Modified Davis classification, image size 848x848.
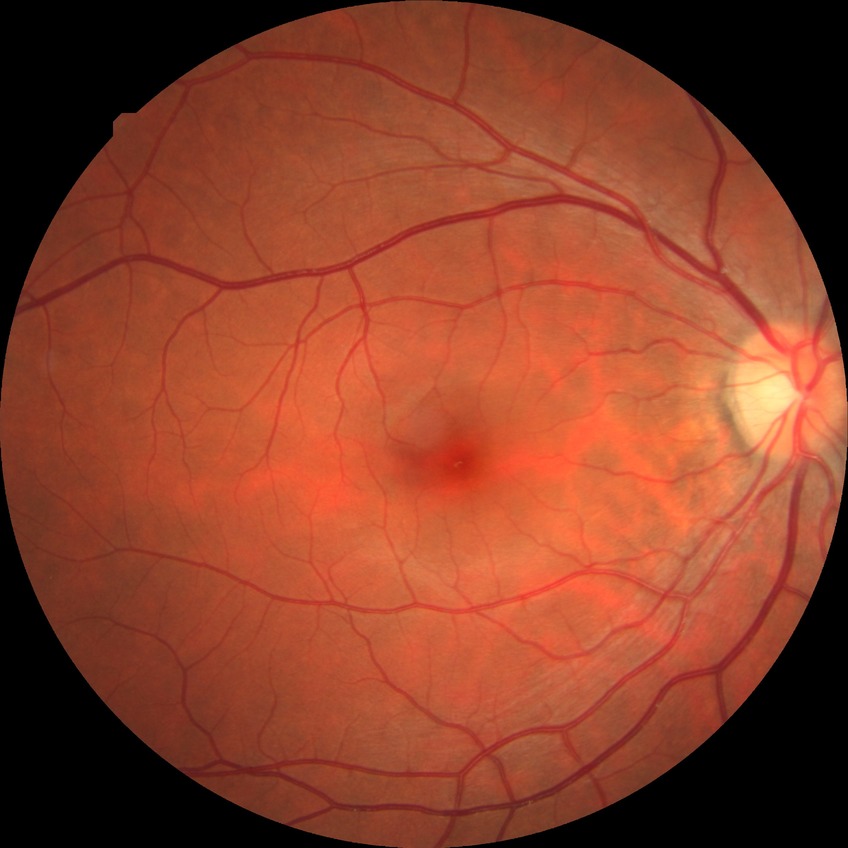
{
  "dr_impression": "negative for DR",
  "davis_grade": "NDR"
}